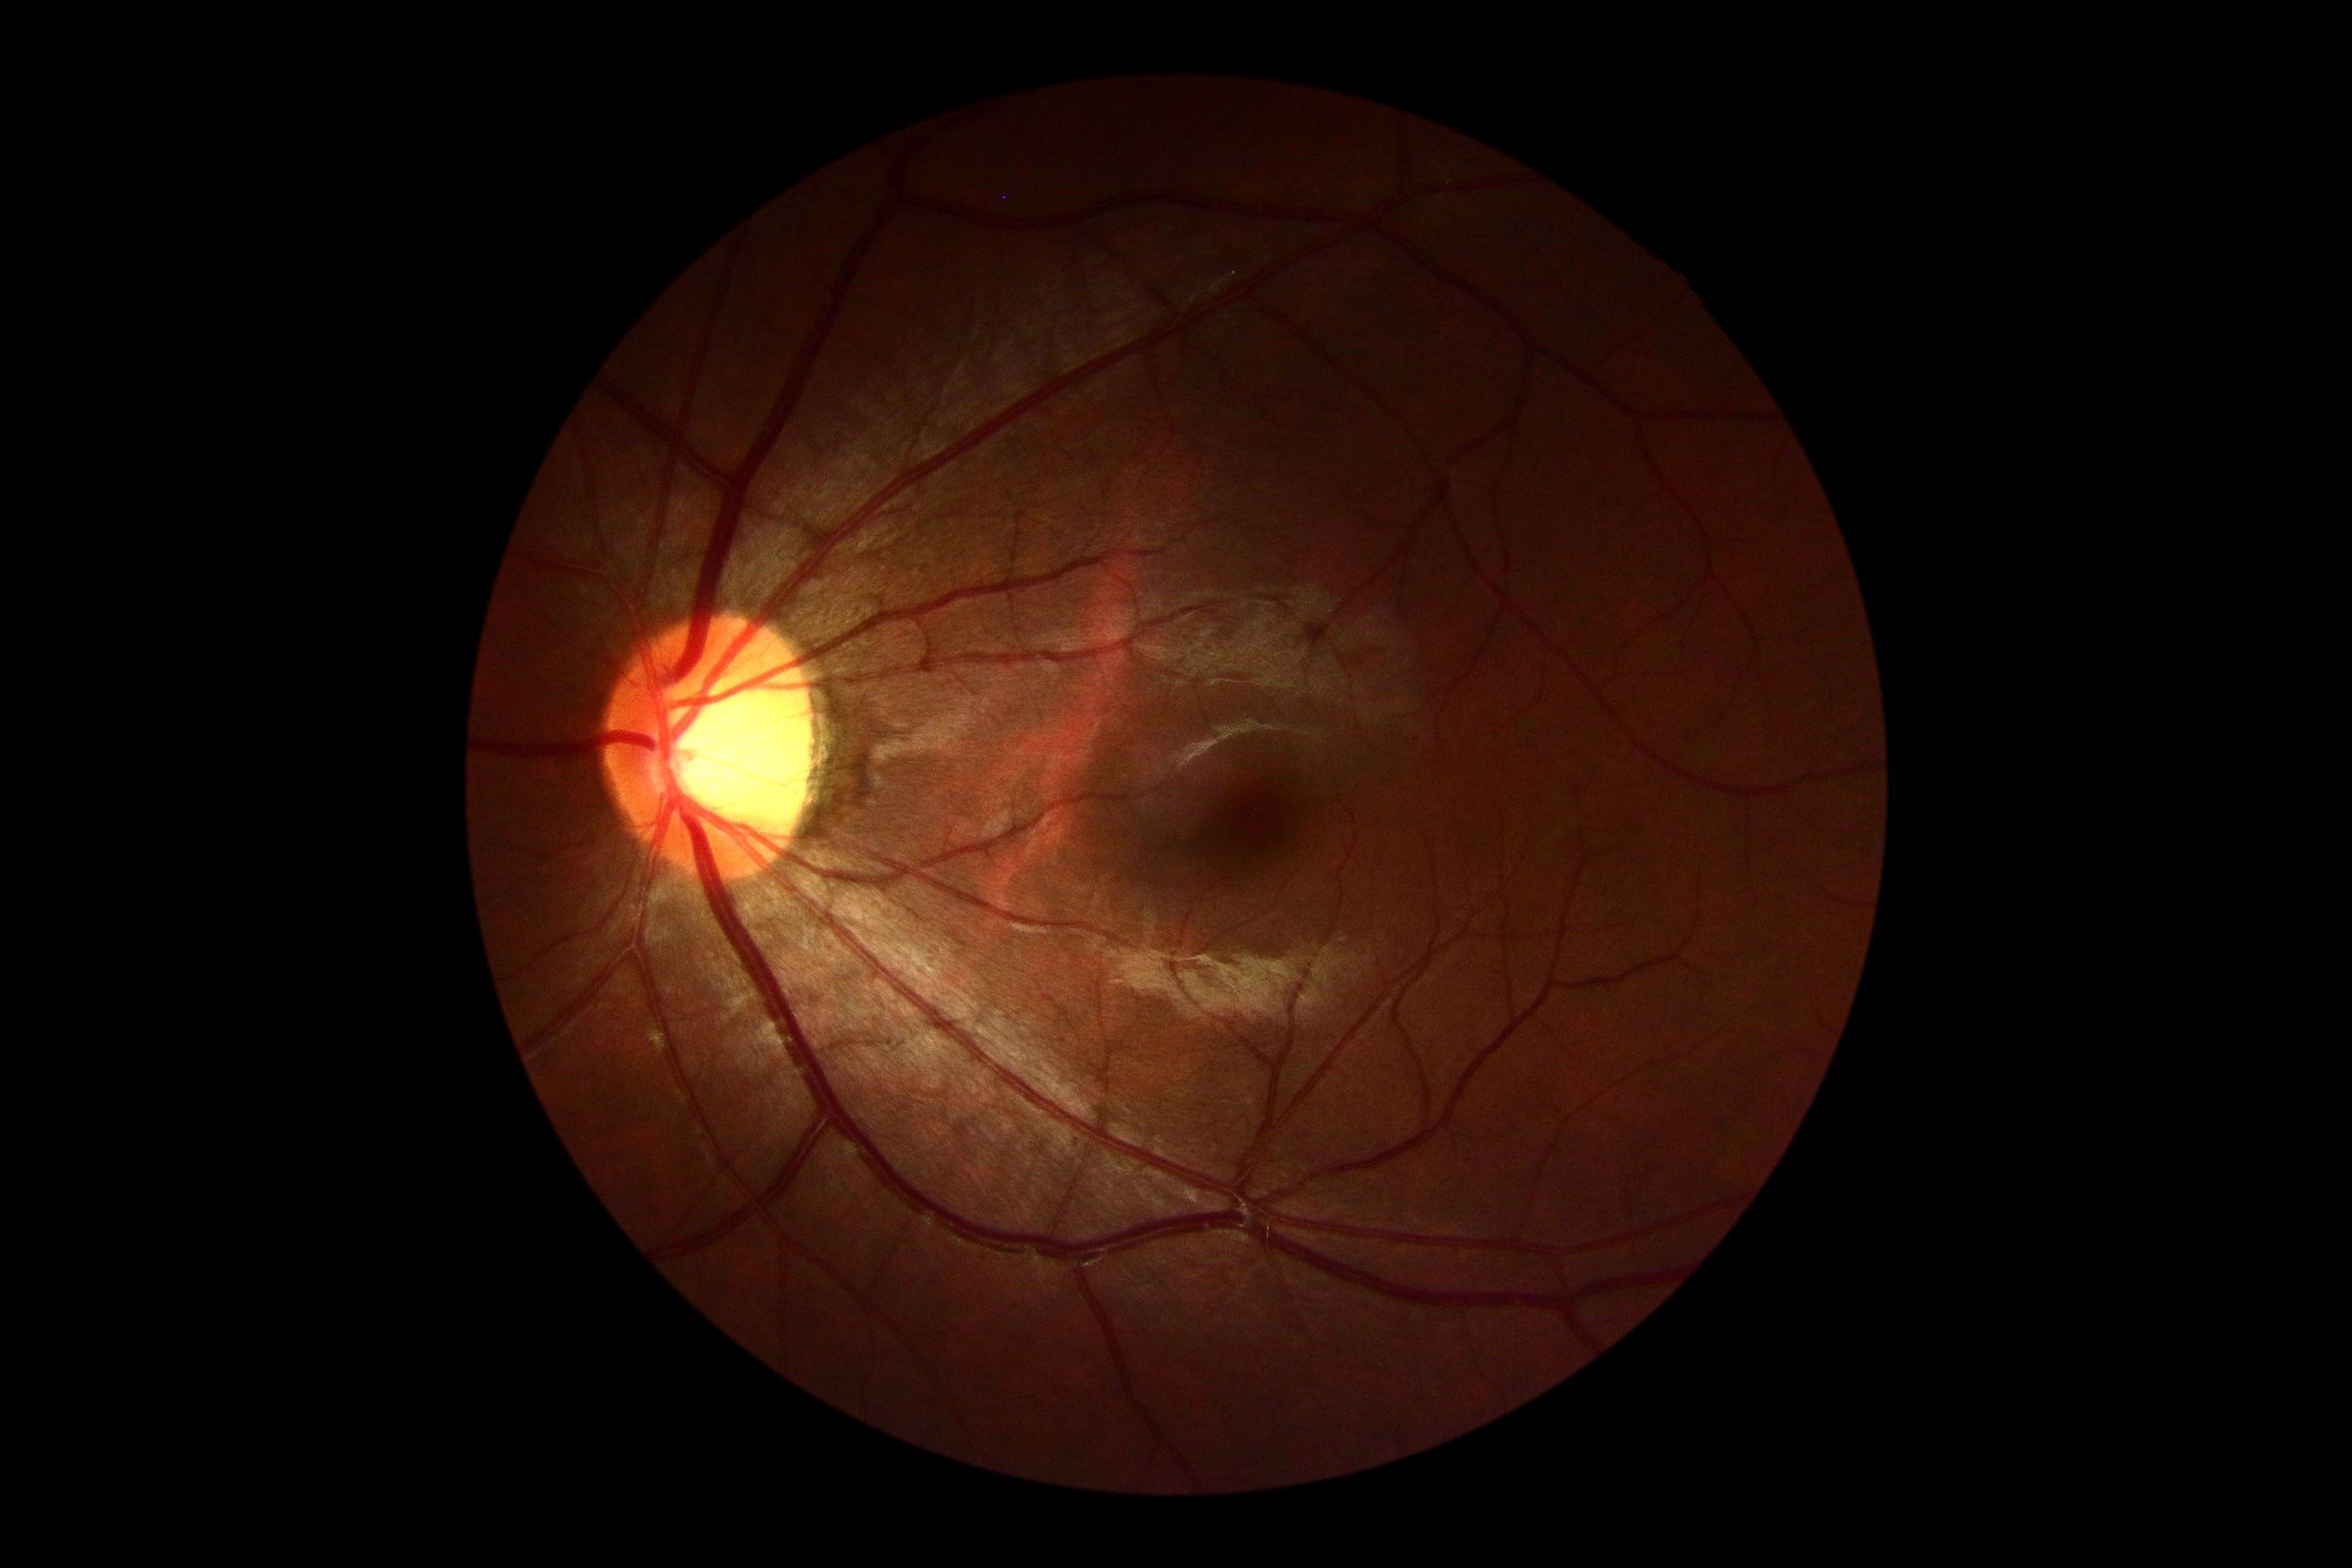

Findings:
- DR impression — negative for DR
- DR grade — 0 (no apparent retinopathy)